Modified Davis grading — 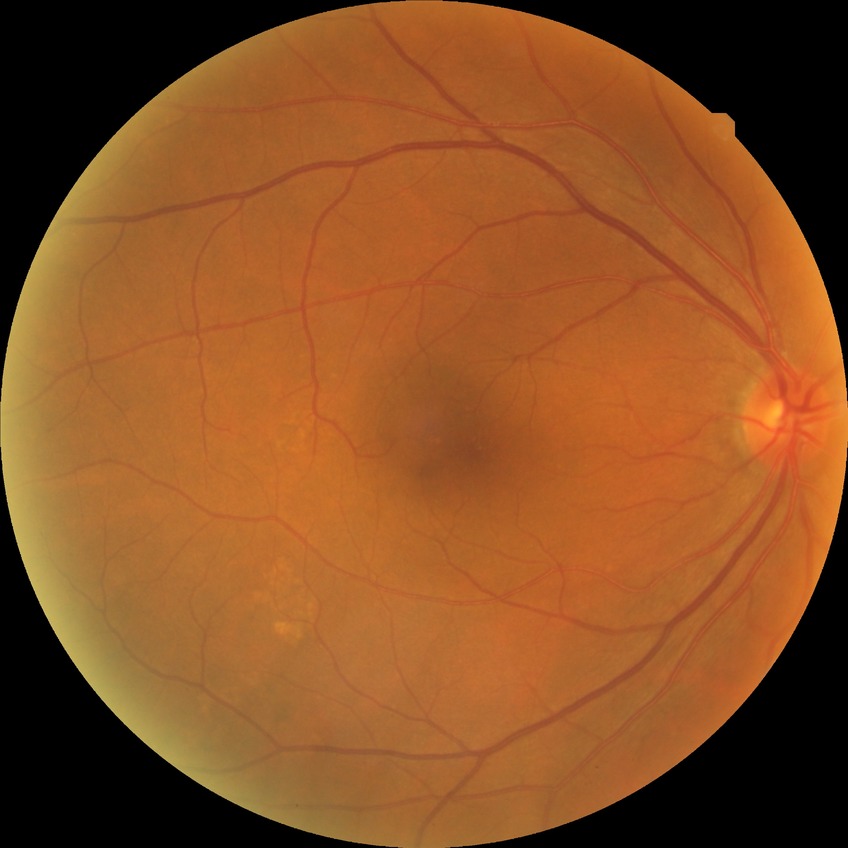 davis_grade: no diabetic retinopathy (NDR)